Infant wide-field retinal image. Clarity RetCam 3, 130° FOV
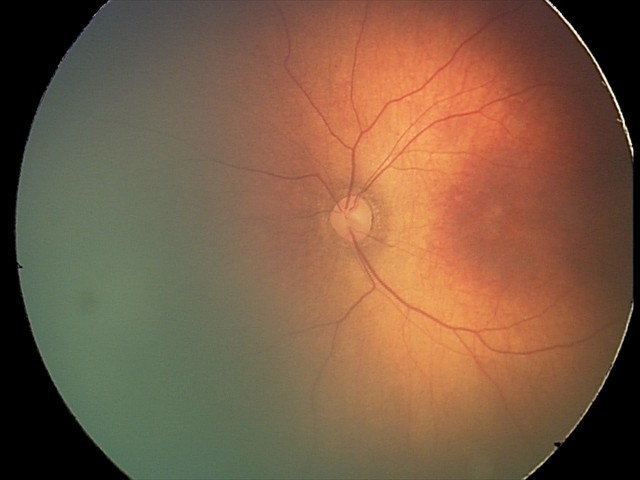
Normal screening examination.